CFP · FOV: 45 degrees · image size 1624x1232: 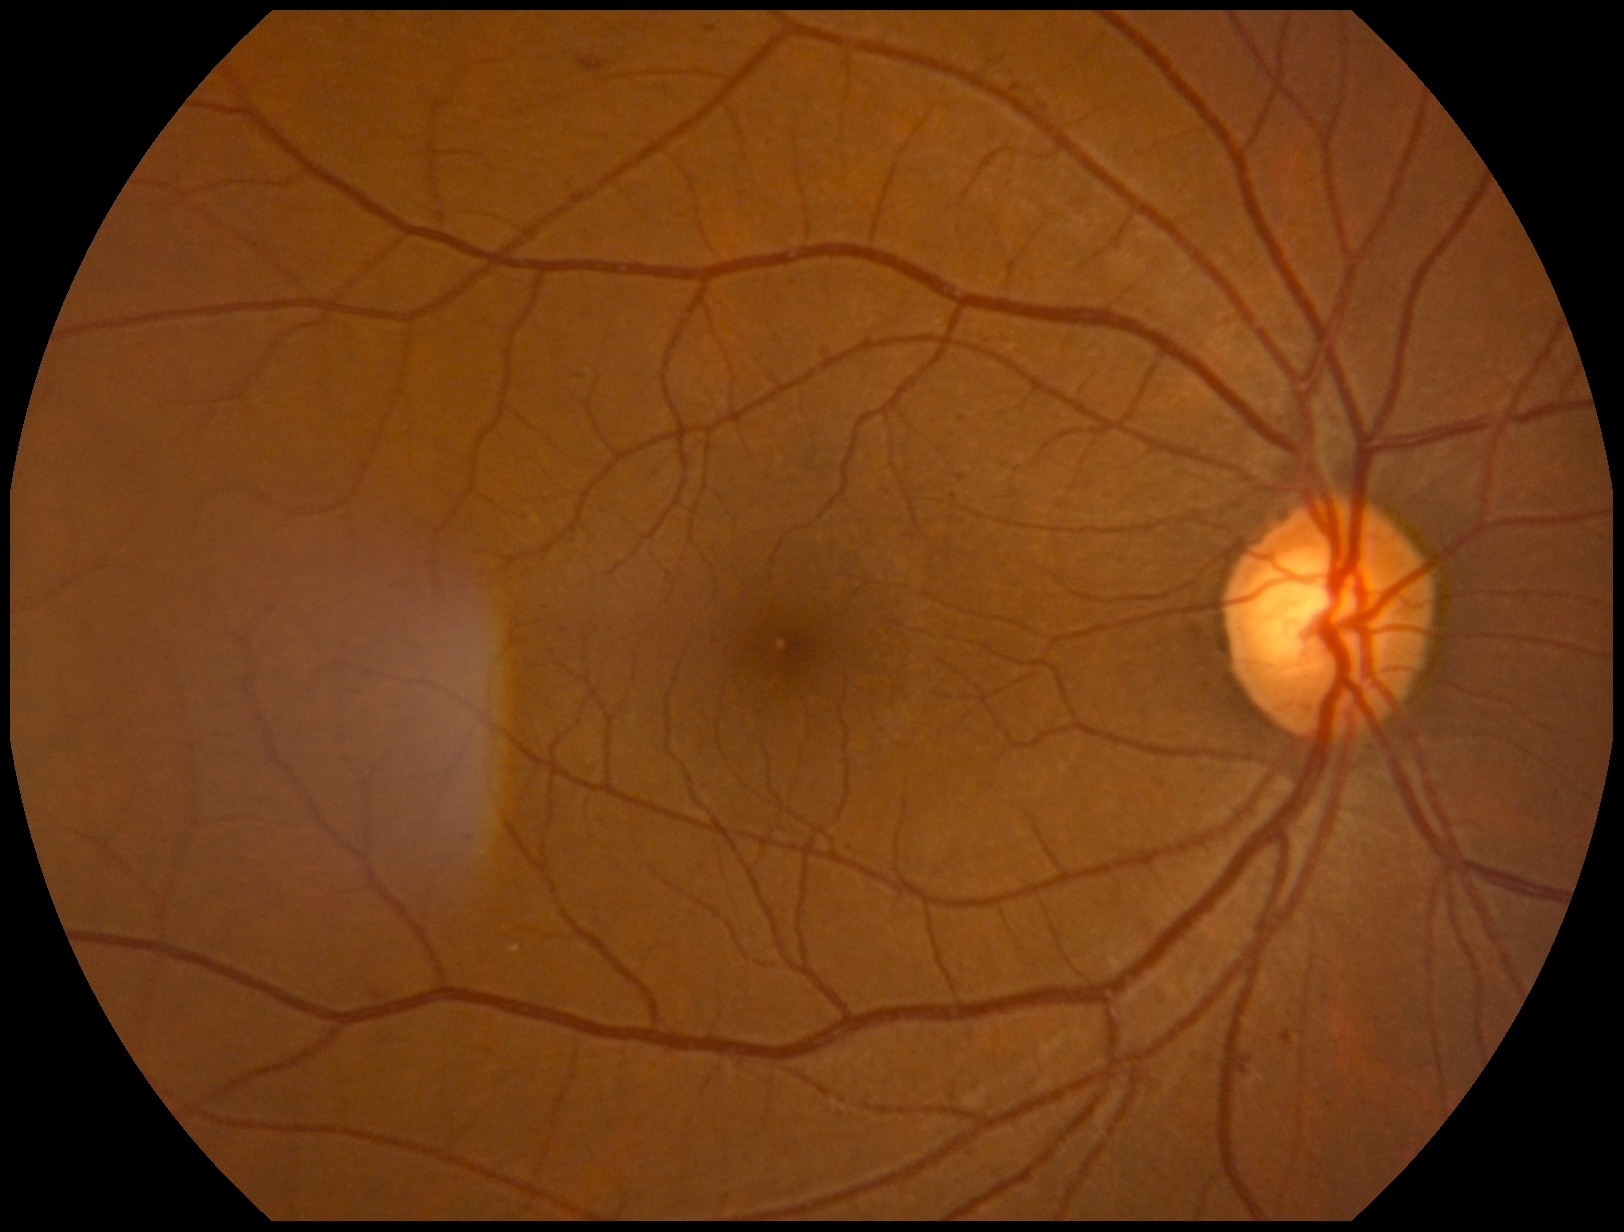 diabetic retinopathy grade: 2 (moderate NPDR).